1380x1382, fundus photo — 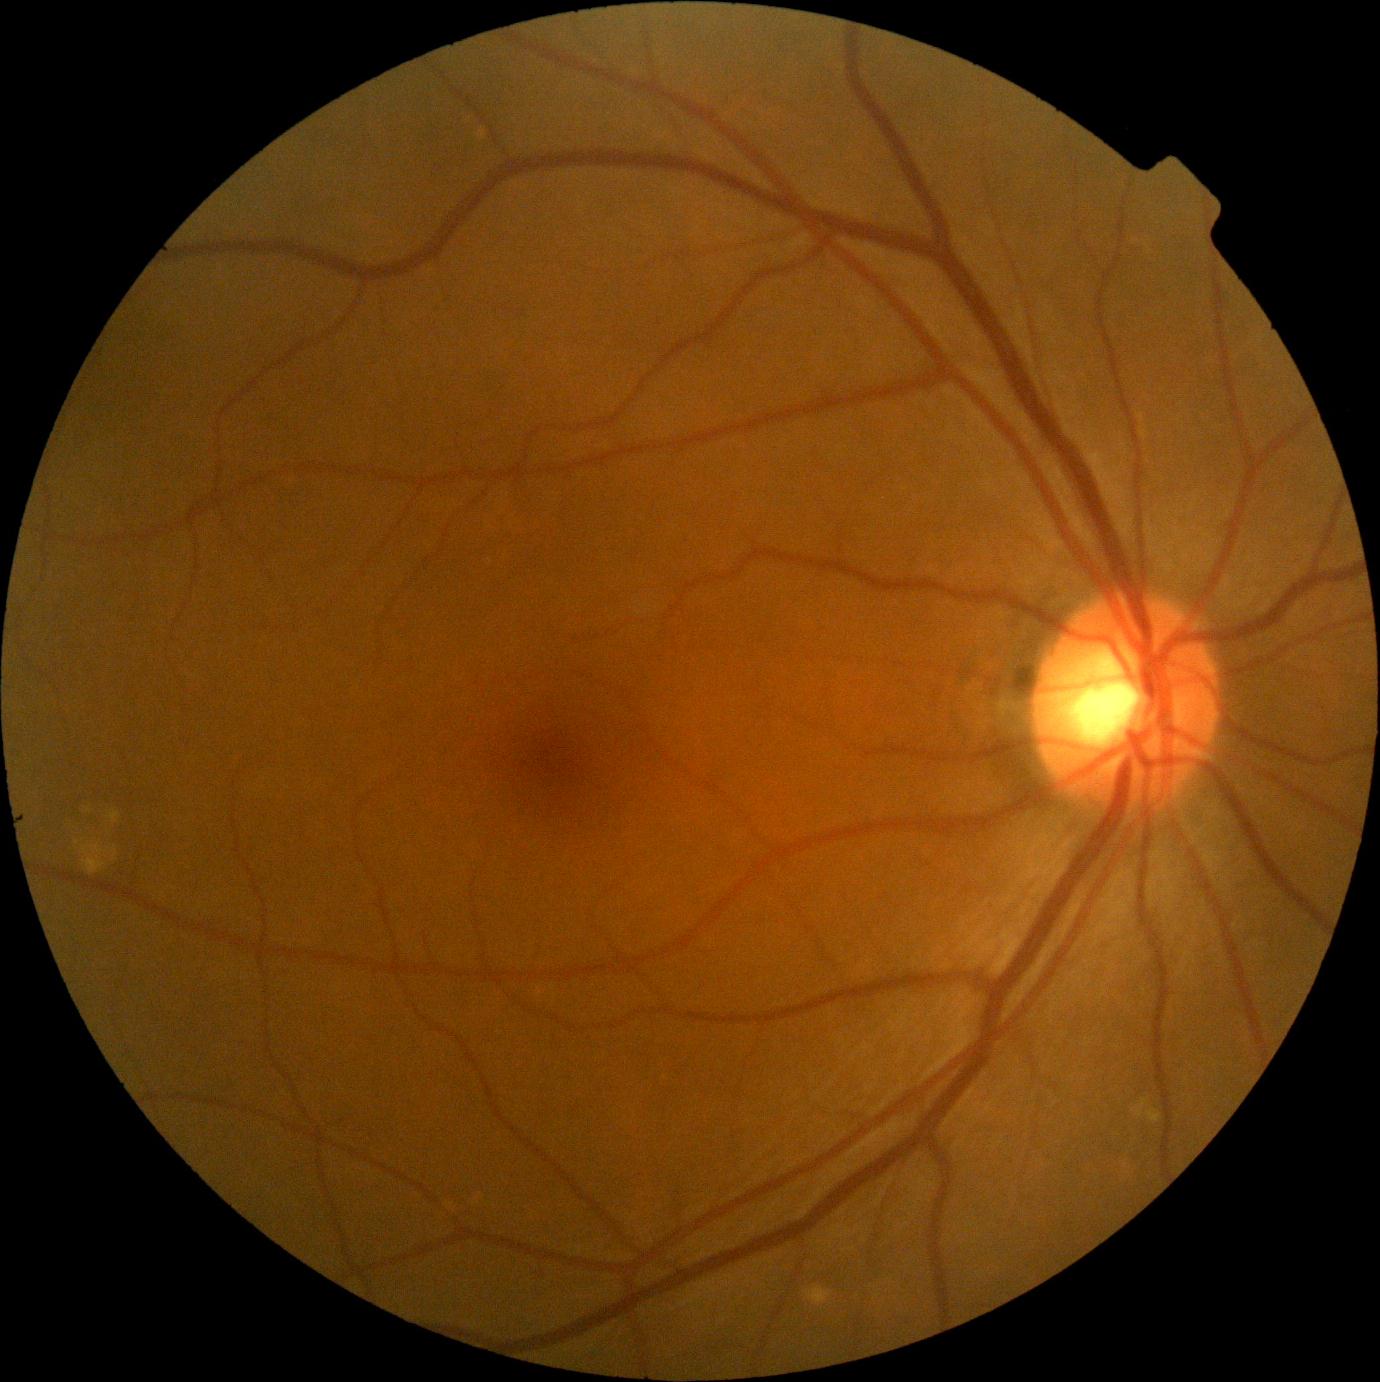

DR impression: no apparent DR; diabetic retinopathy (DR): no apparent retinopathy (grade 0) — no visible signs of diabetic retinopathy.